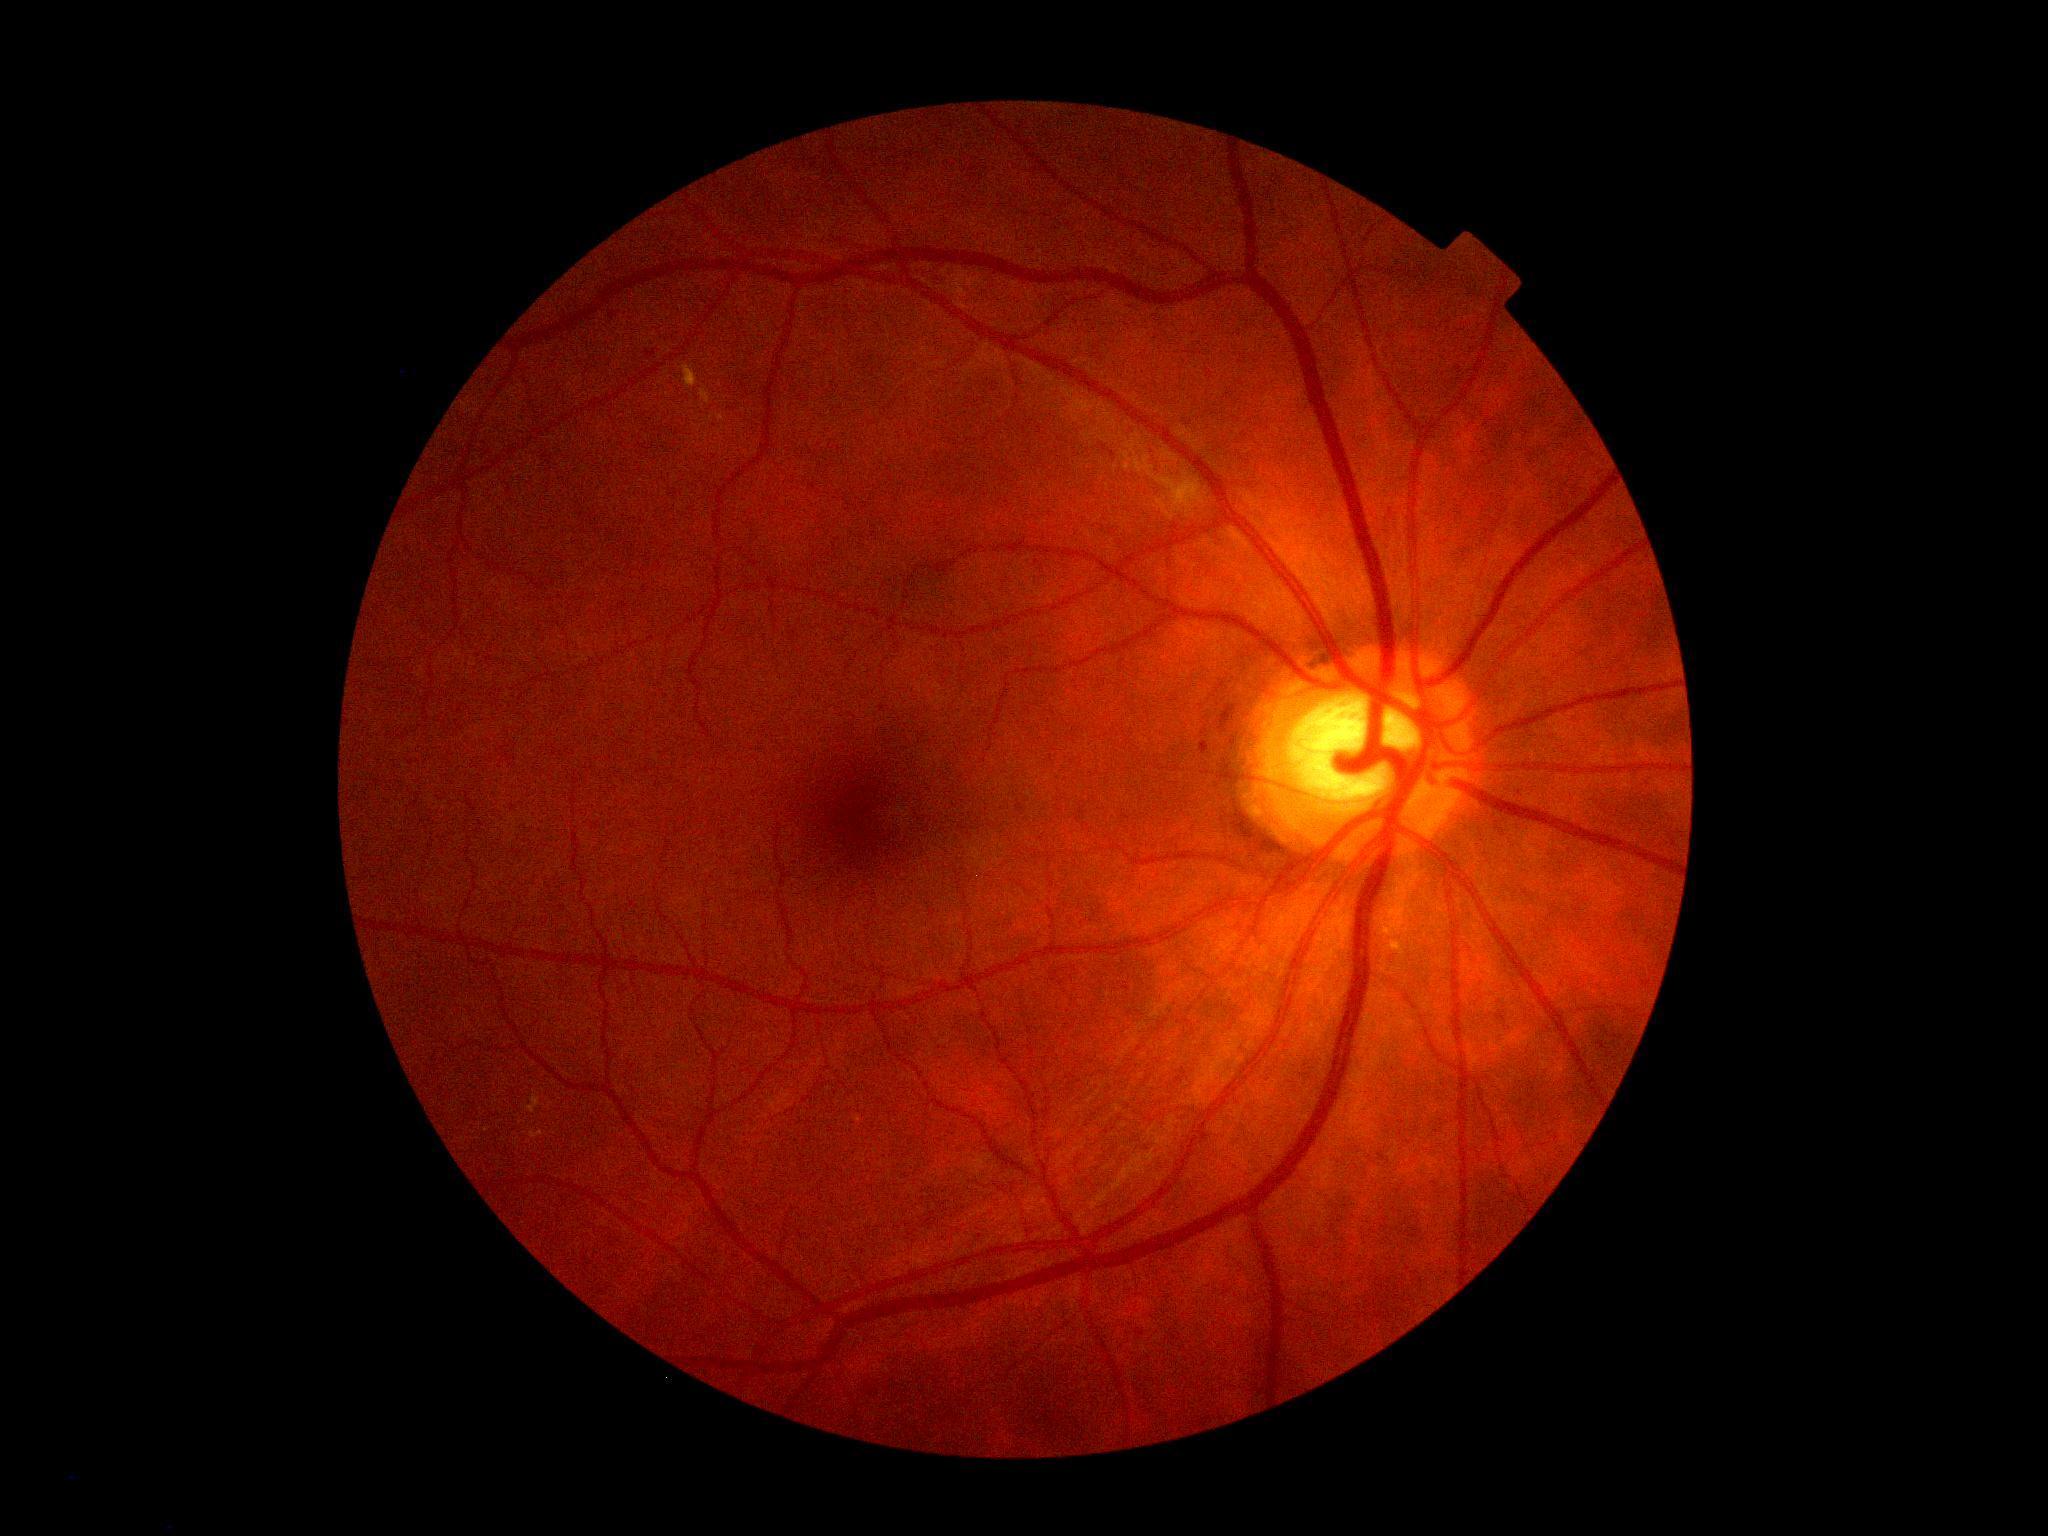
DR: grade 2 (moderate NPDR)